50-degree field of view
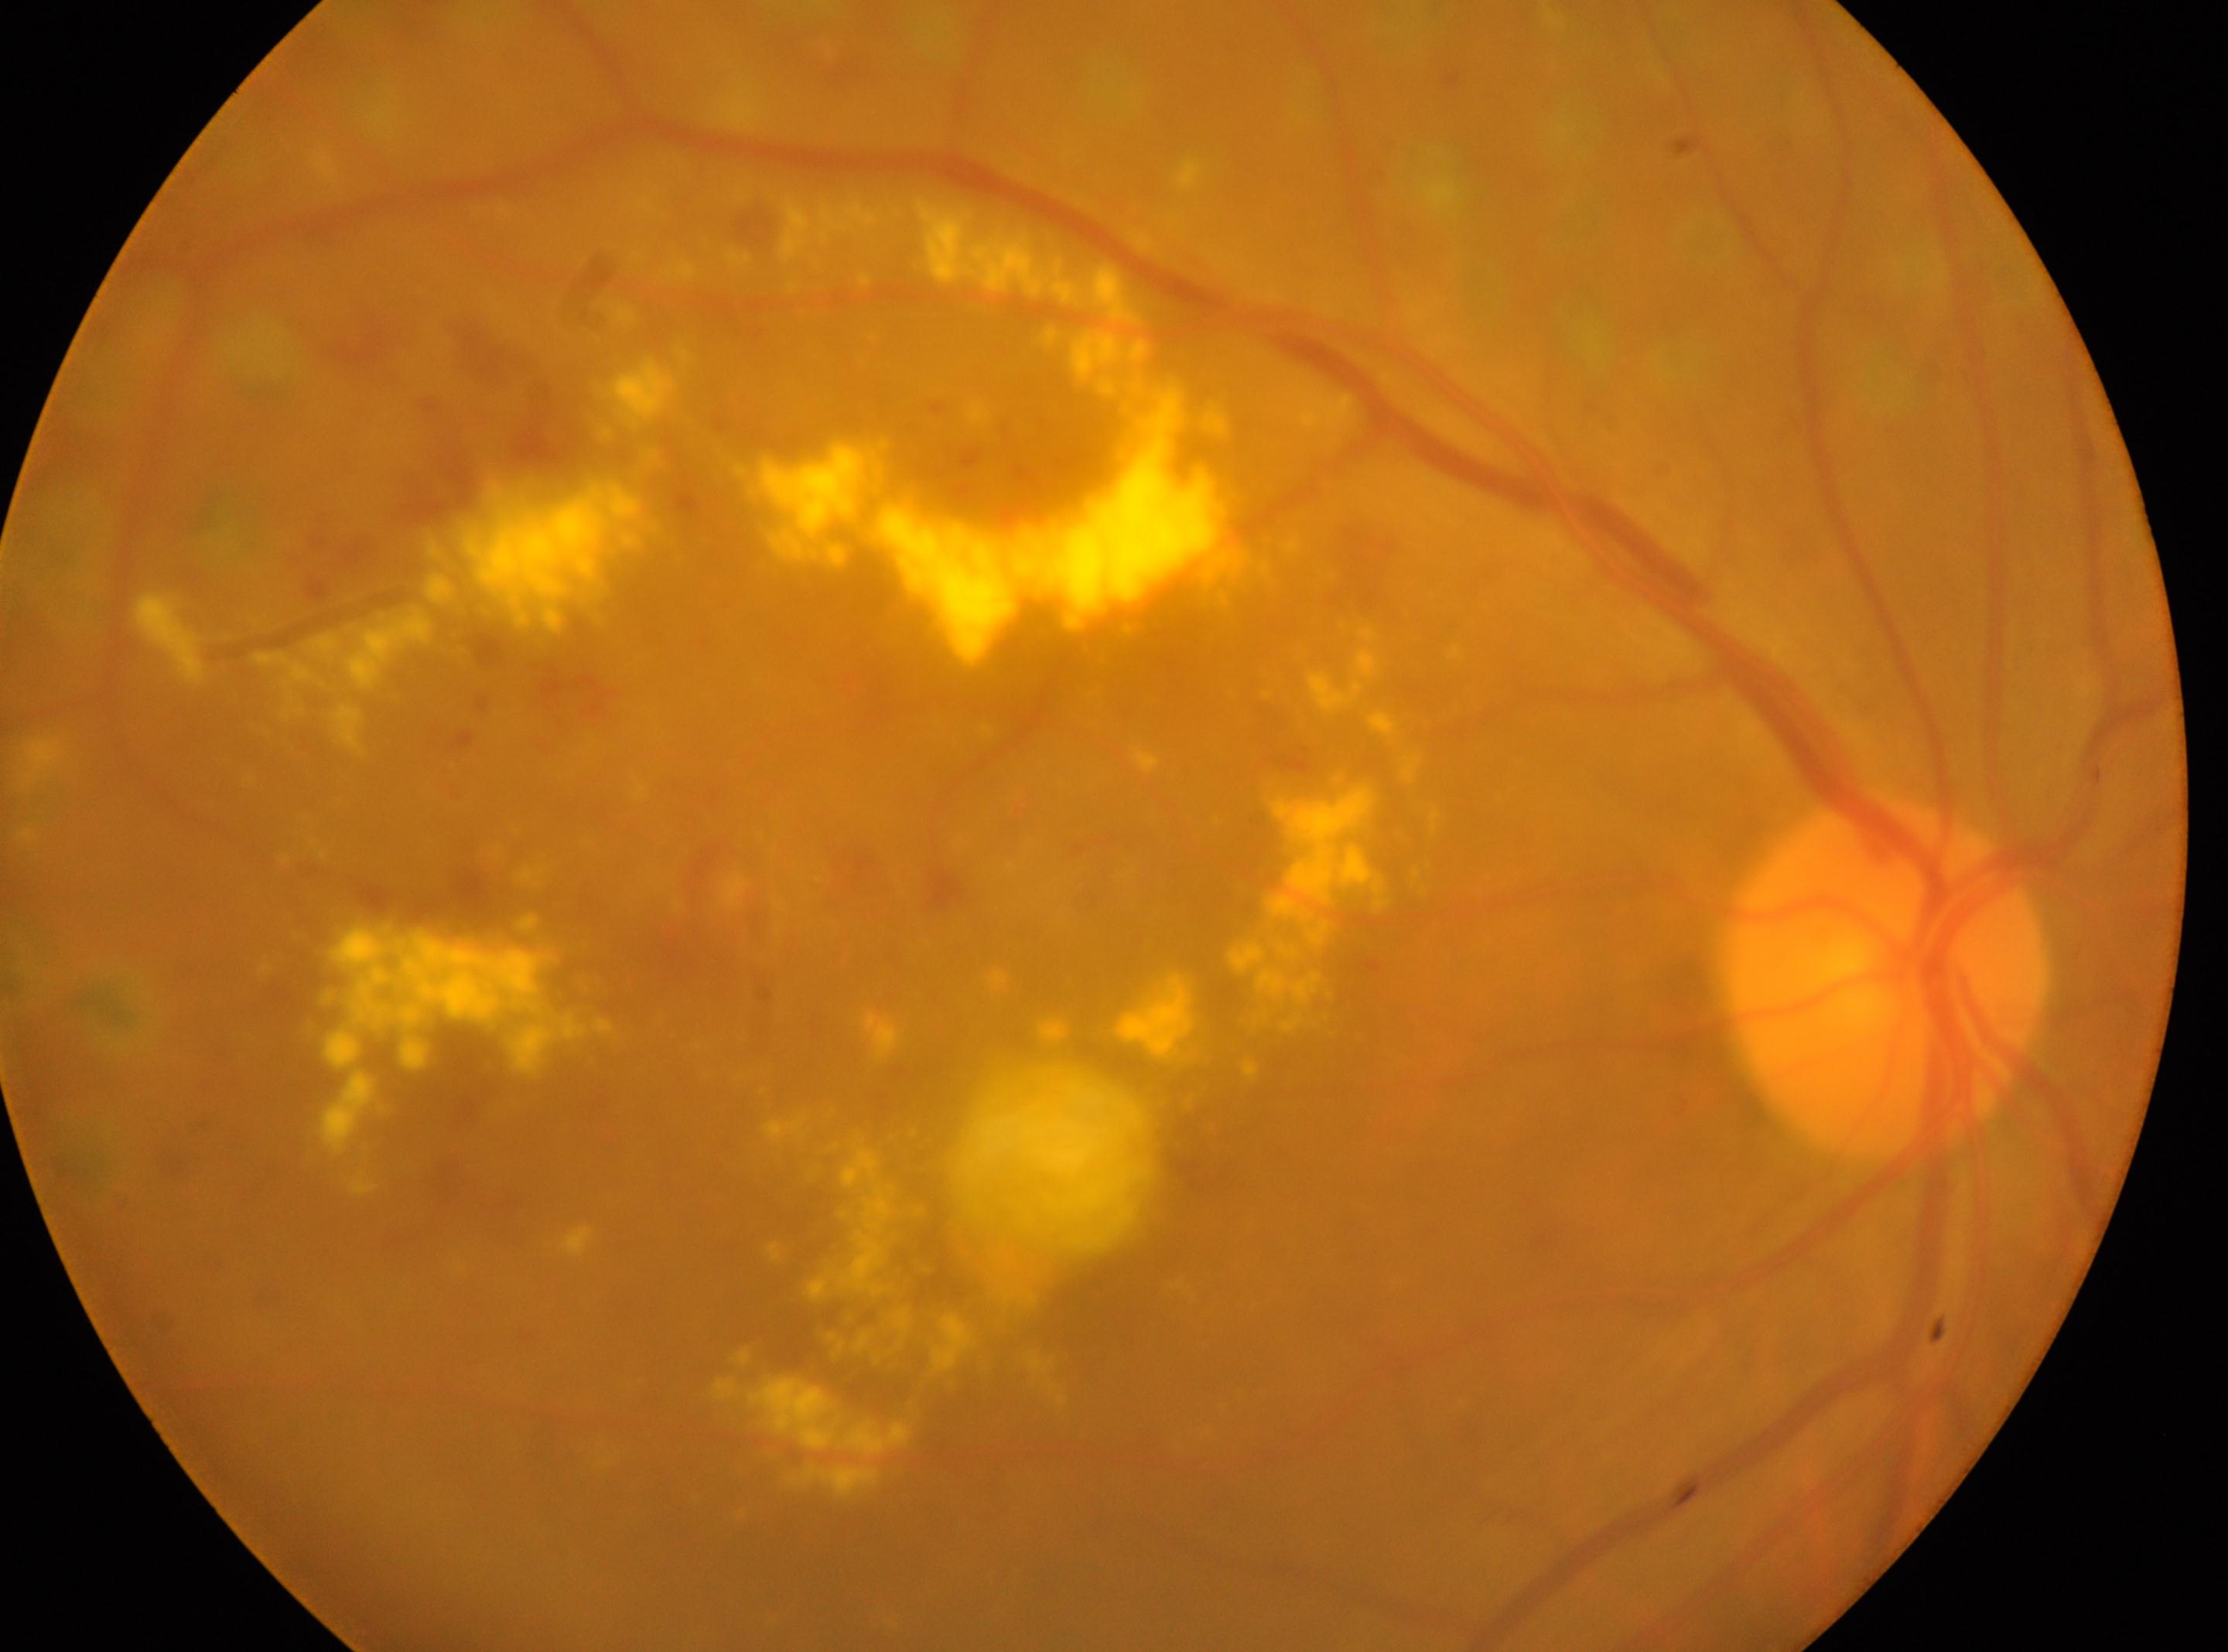 Imaged eye: right eye. ONH located at (x: 1886, y: 981). Fovea: (x: 1024, y: 1052). DR stage is post-laser DR, underlying severity moderate NPDR (grade 2).